45-degree field of view · acquired with a NIDEK AFC-230 · 848 x 848 pixels · posterior pole color fundus photograph · nonmydriatic:
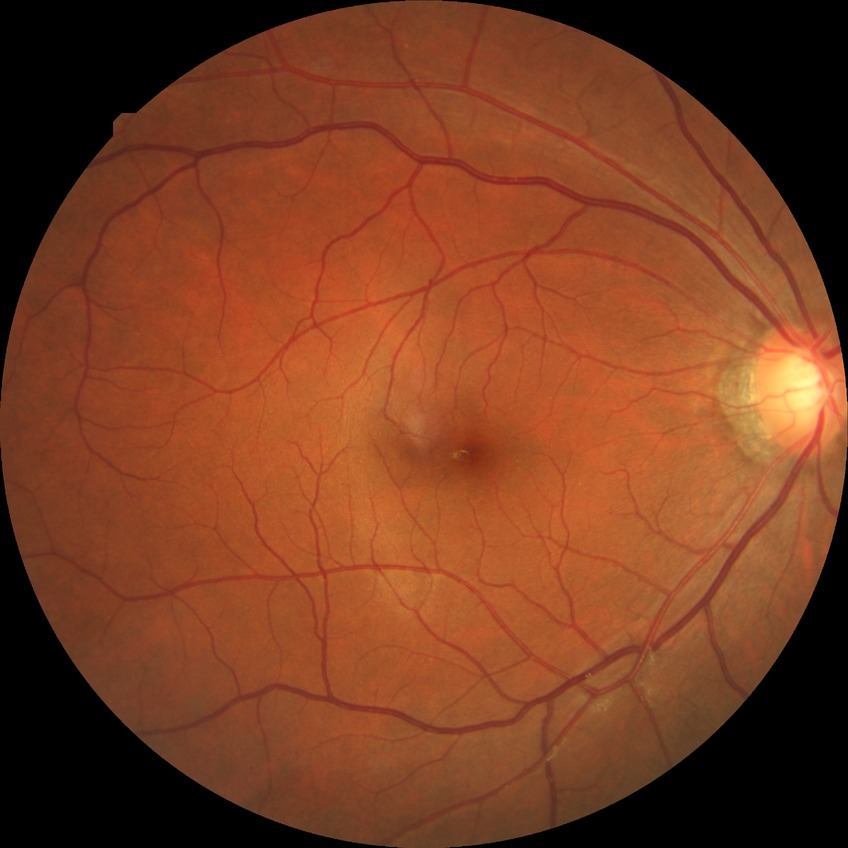

diabetic retinopathy (DR)@no diabetic retinopathy (NDR).